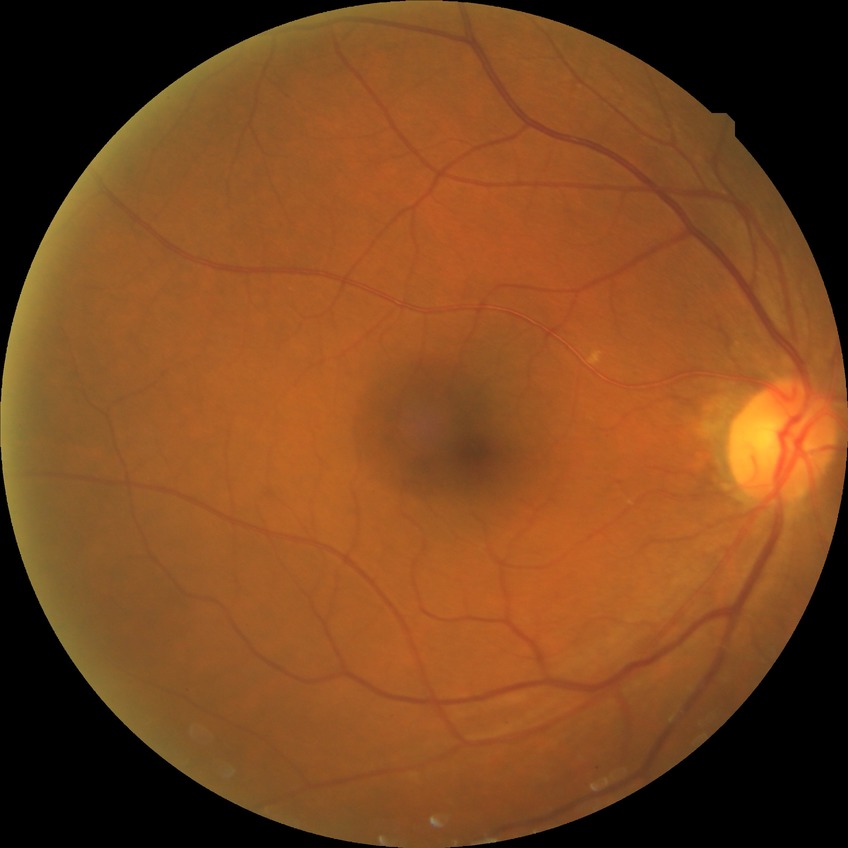 No apparent diabetic retinopathy. DR severity is NDR.